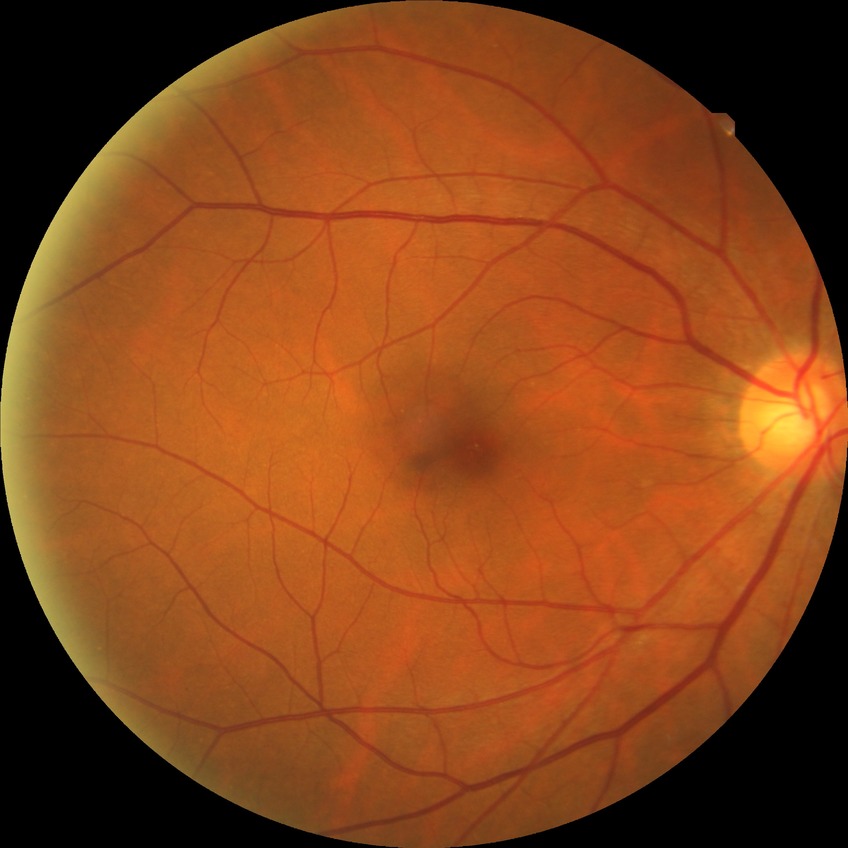
diabetic retinopathy (DR)@NDR (no diabetic retinopathy).